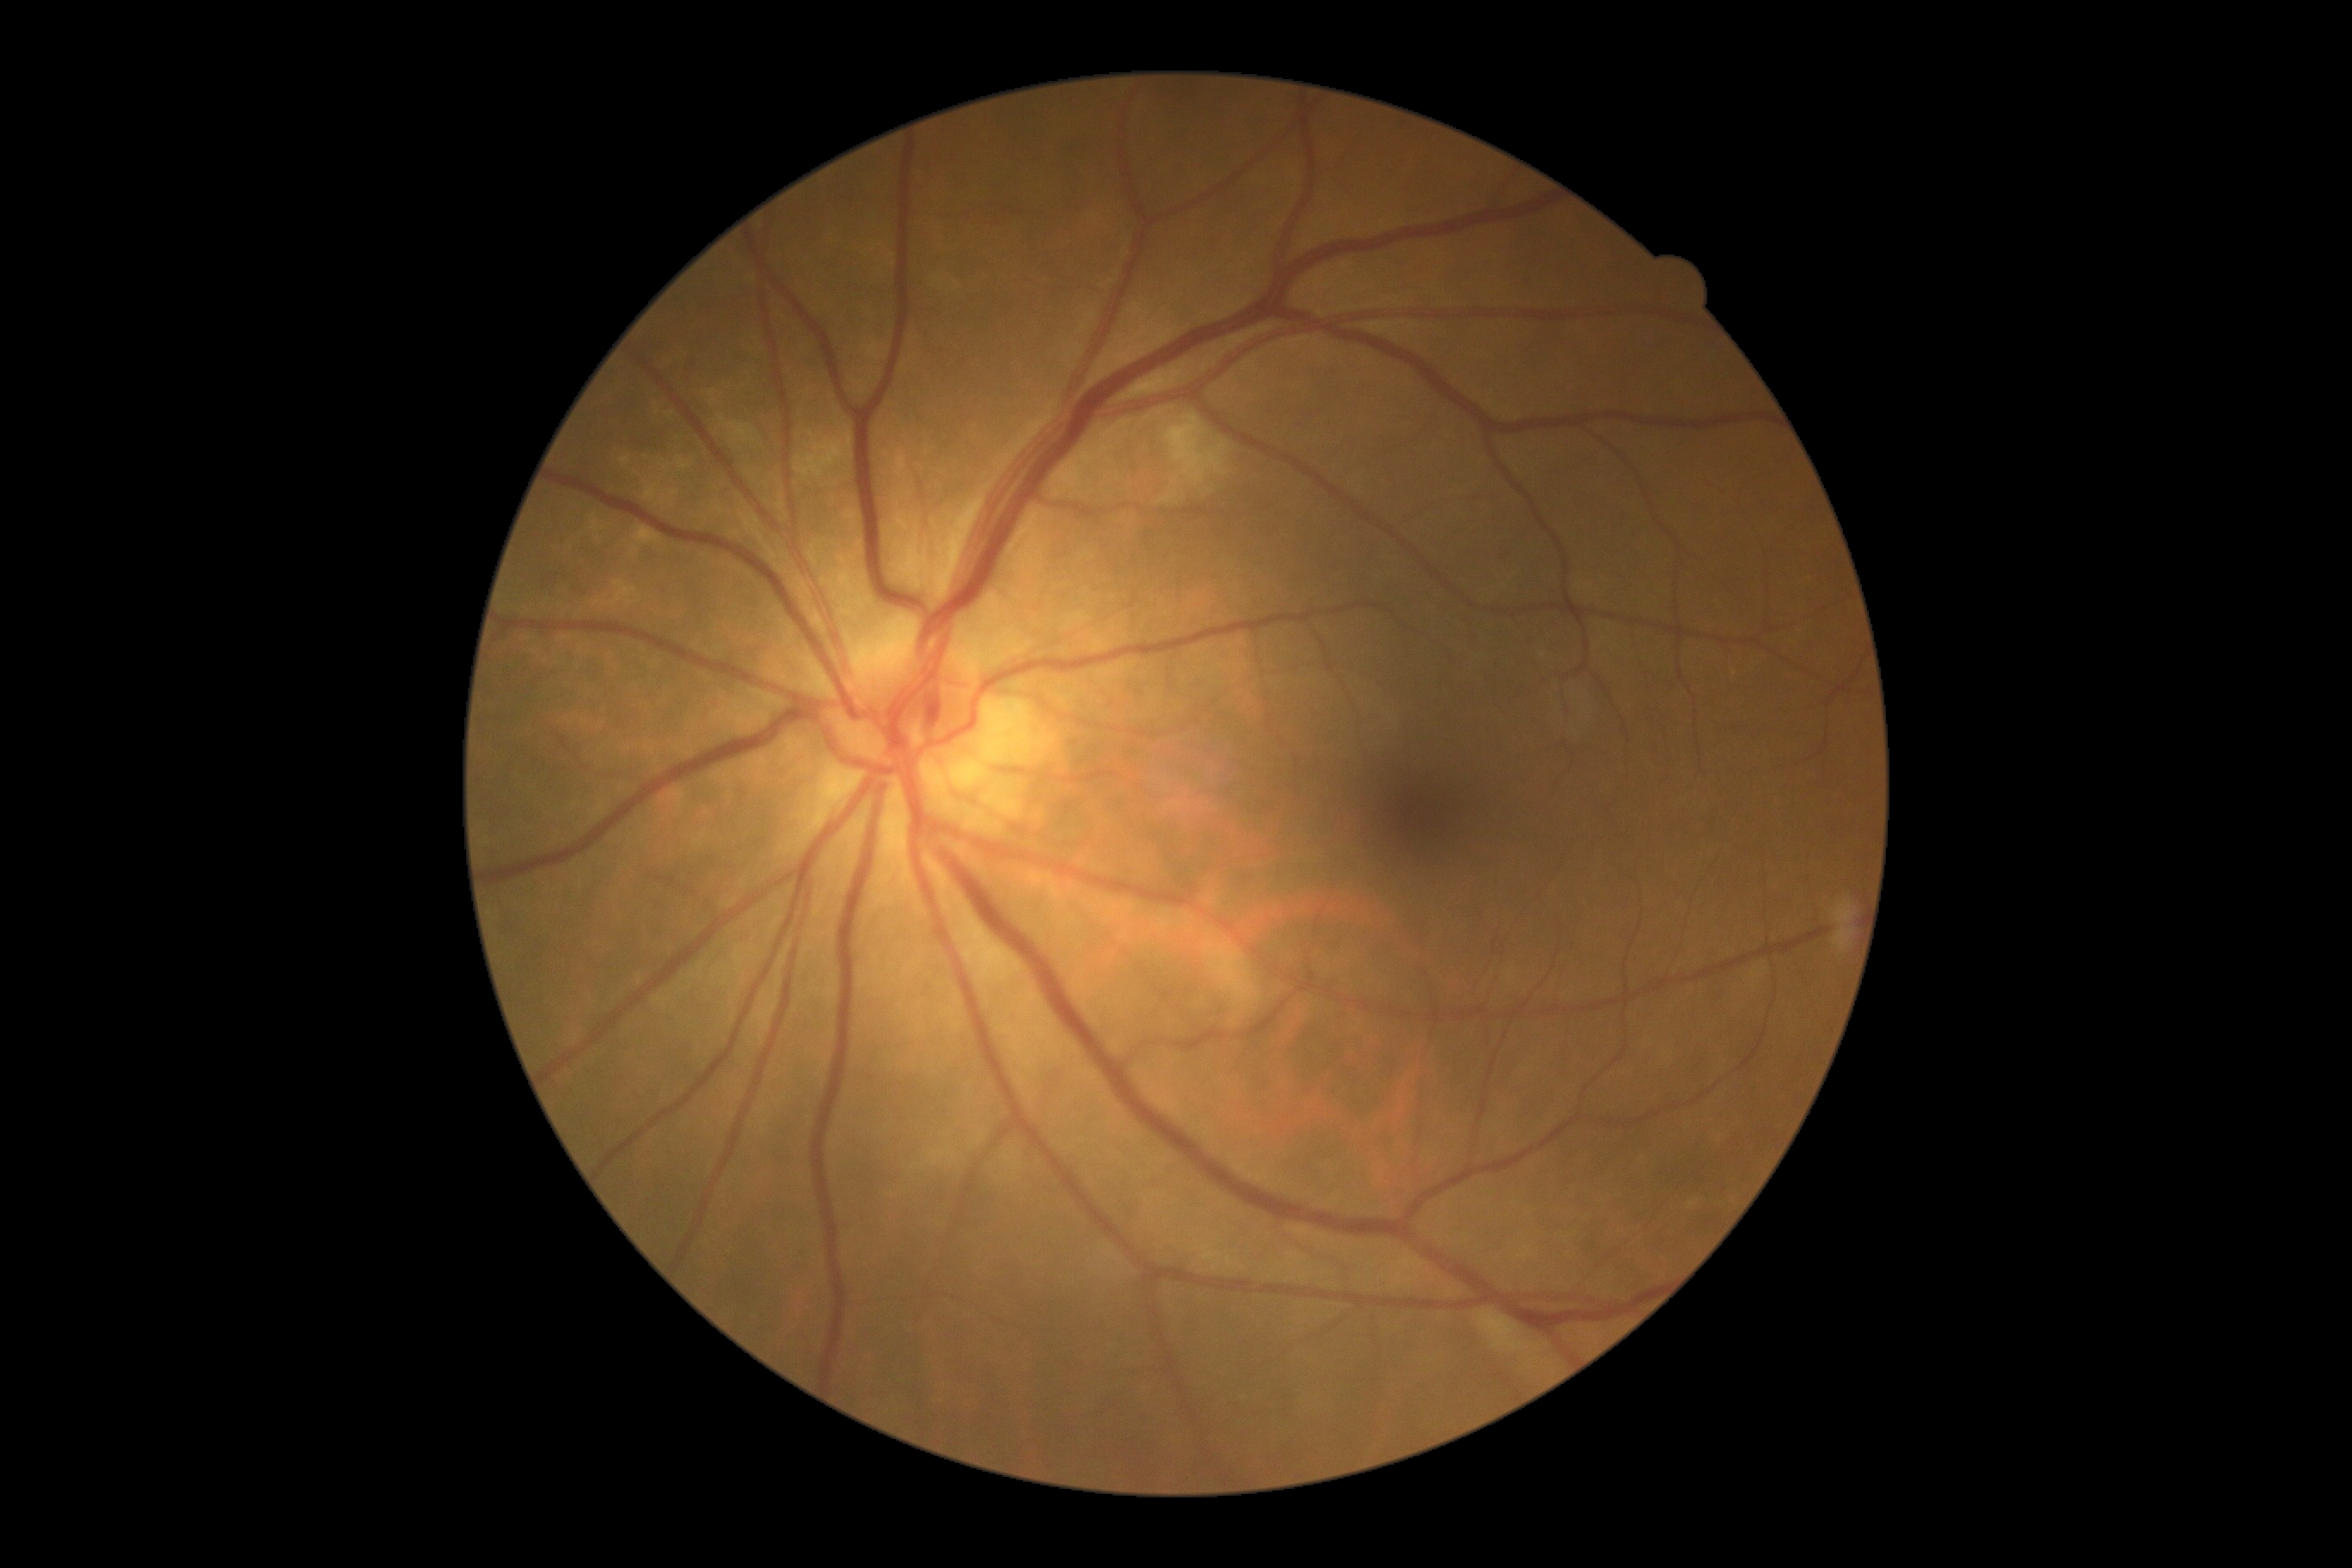
DR stage is grade 2 (moderate NPDR).